Graded on the modified Davis scale:
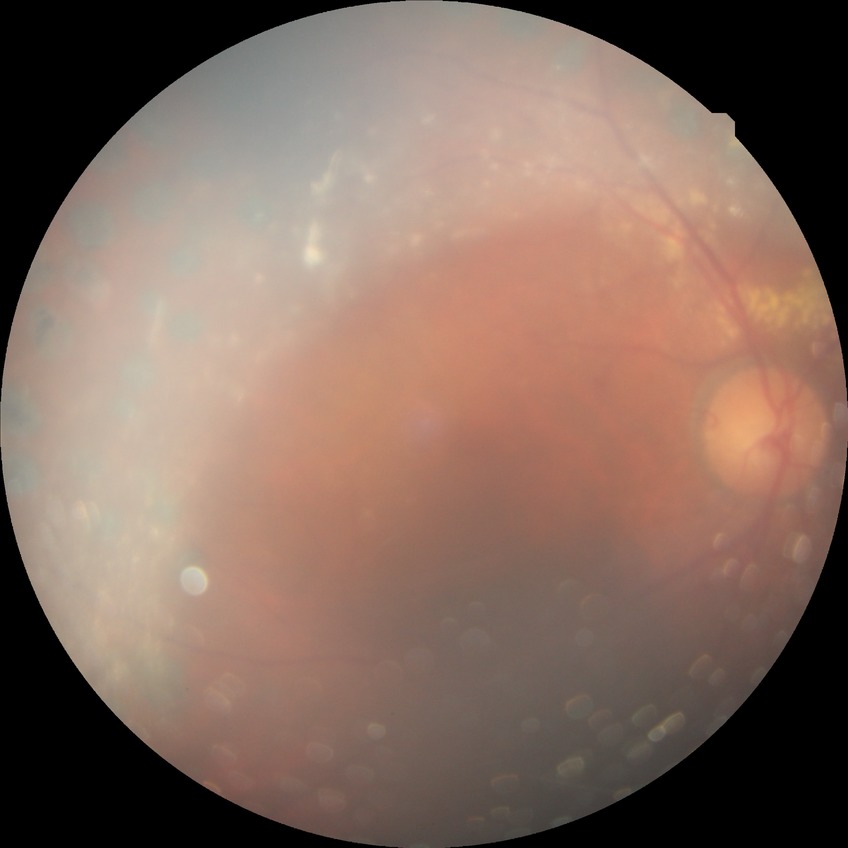 Modified Davis grading: proliferative diabetic retinopathy.